848 x 848 pixels, NIDEK AFC-230 fundus camera, nonmydriatic fundus photograph, 45° field of view: 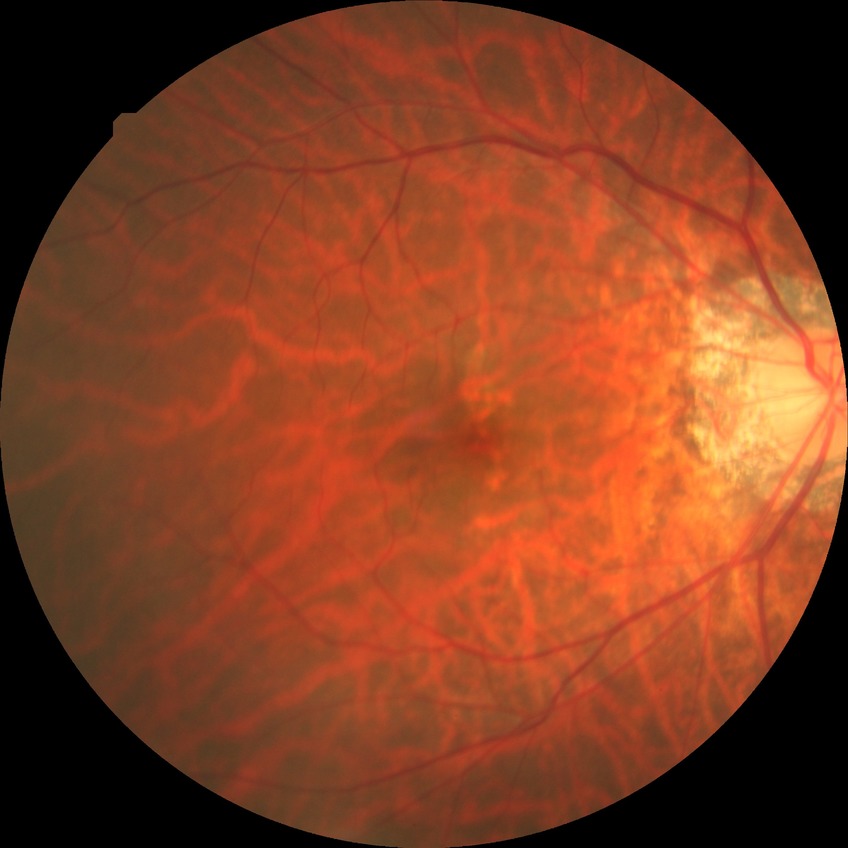

– diabetic retinopathy (DR): NDR (no diabetic retinopathy)